Retinal fundus photograph · 1936x1296px — 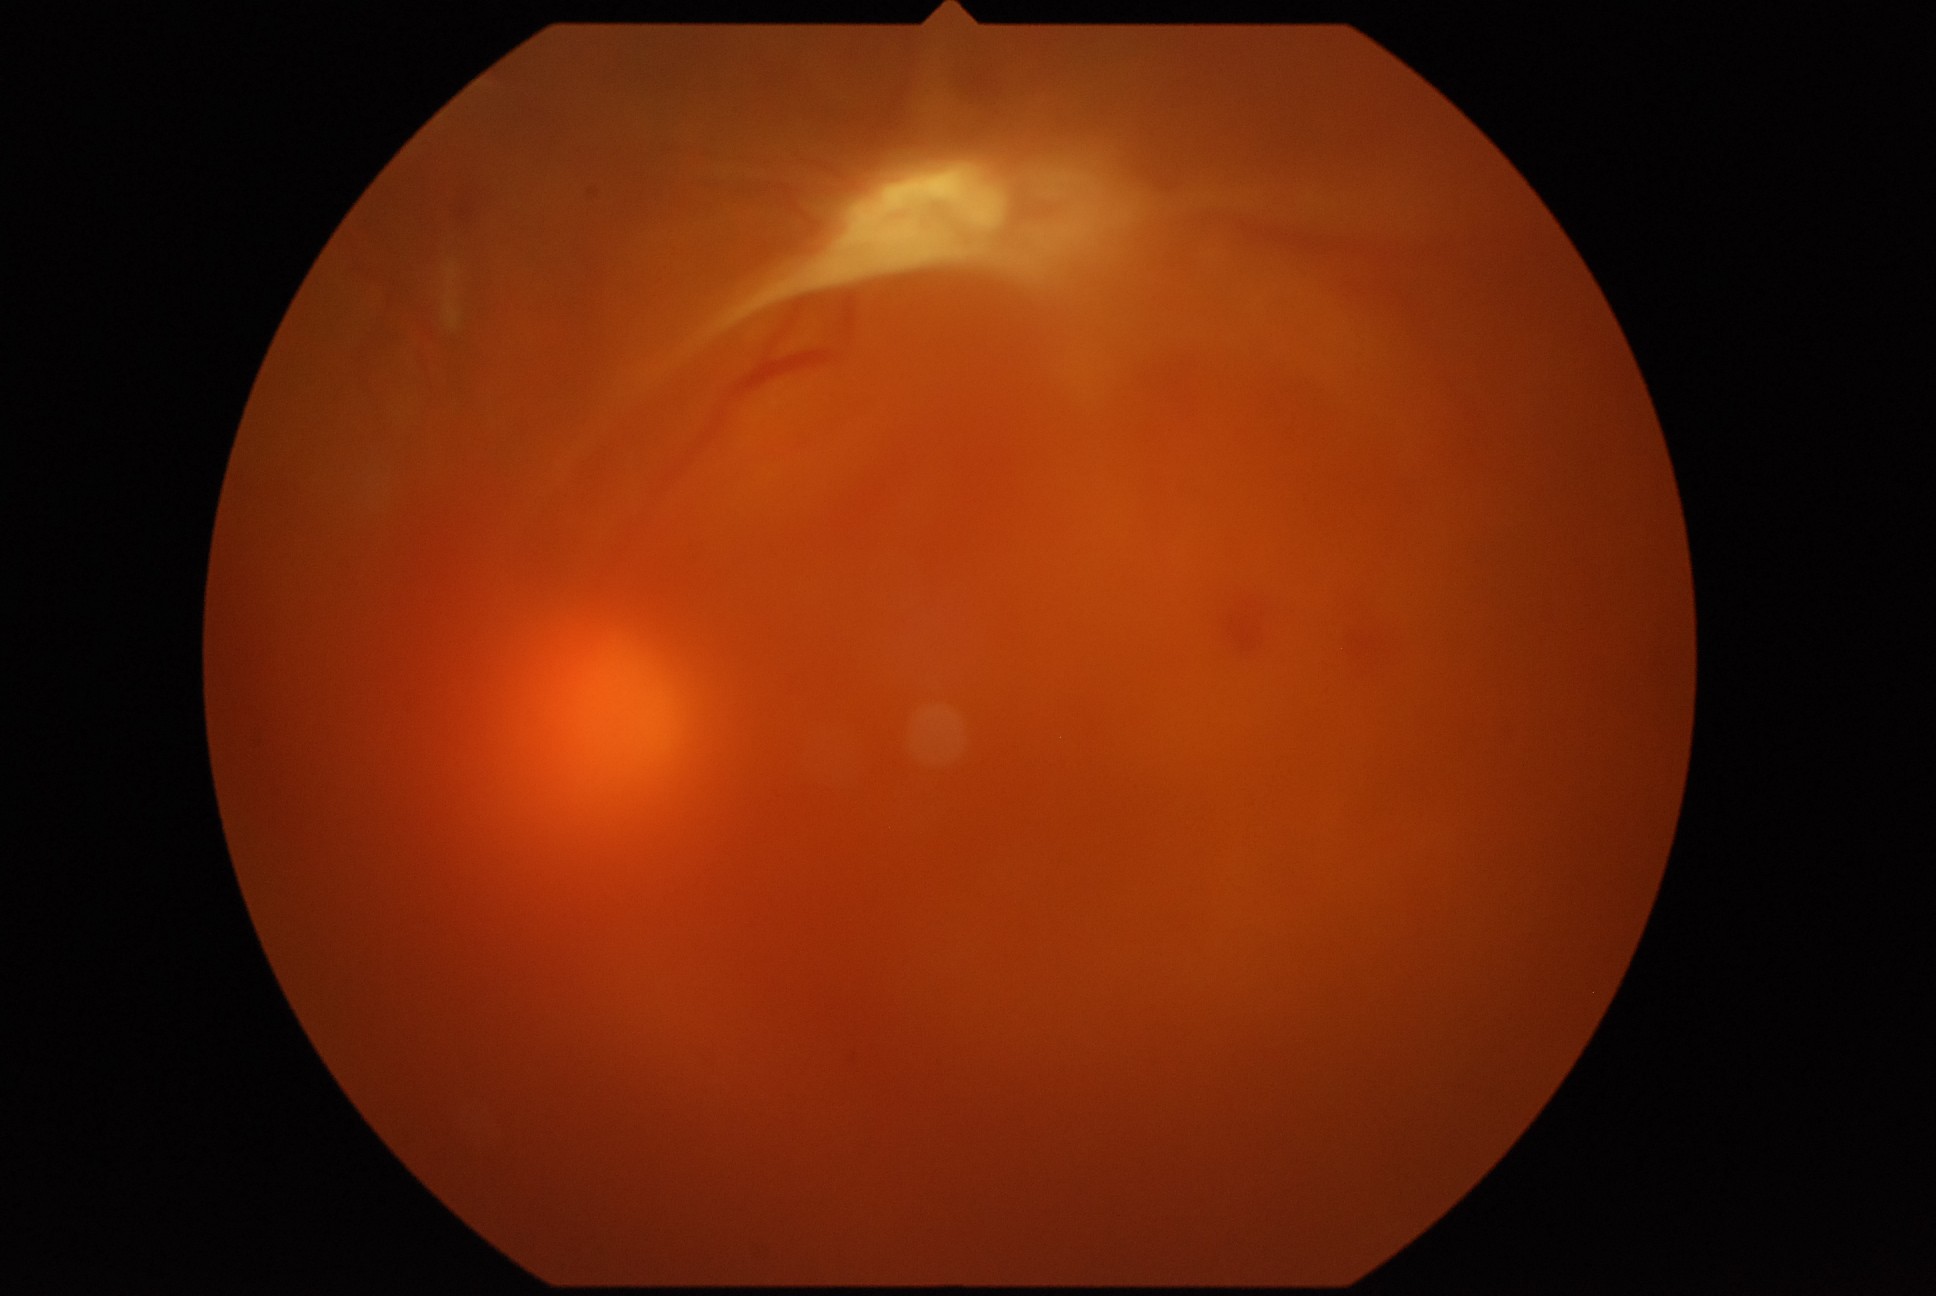
DR class: proliferative diabetic retinopathy. Diabetic retinopathy severity is proliferative diabetic retinopathy (grade 4).